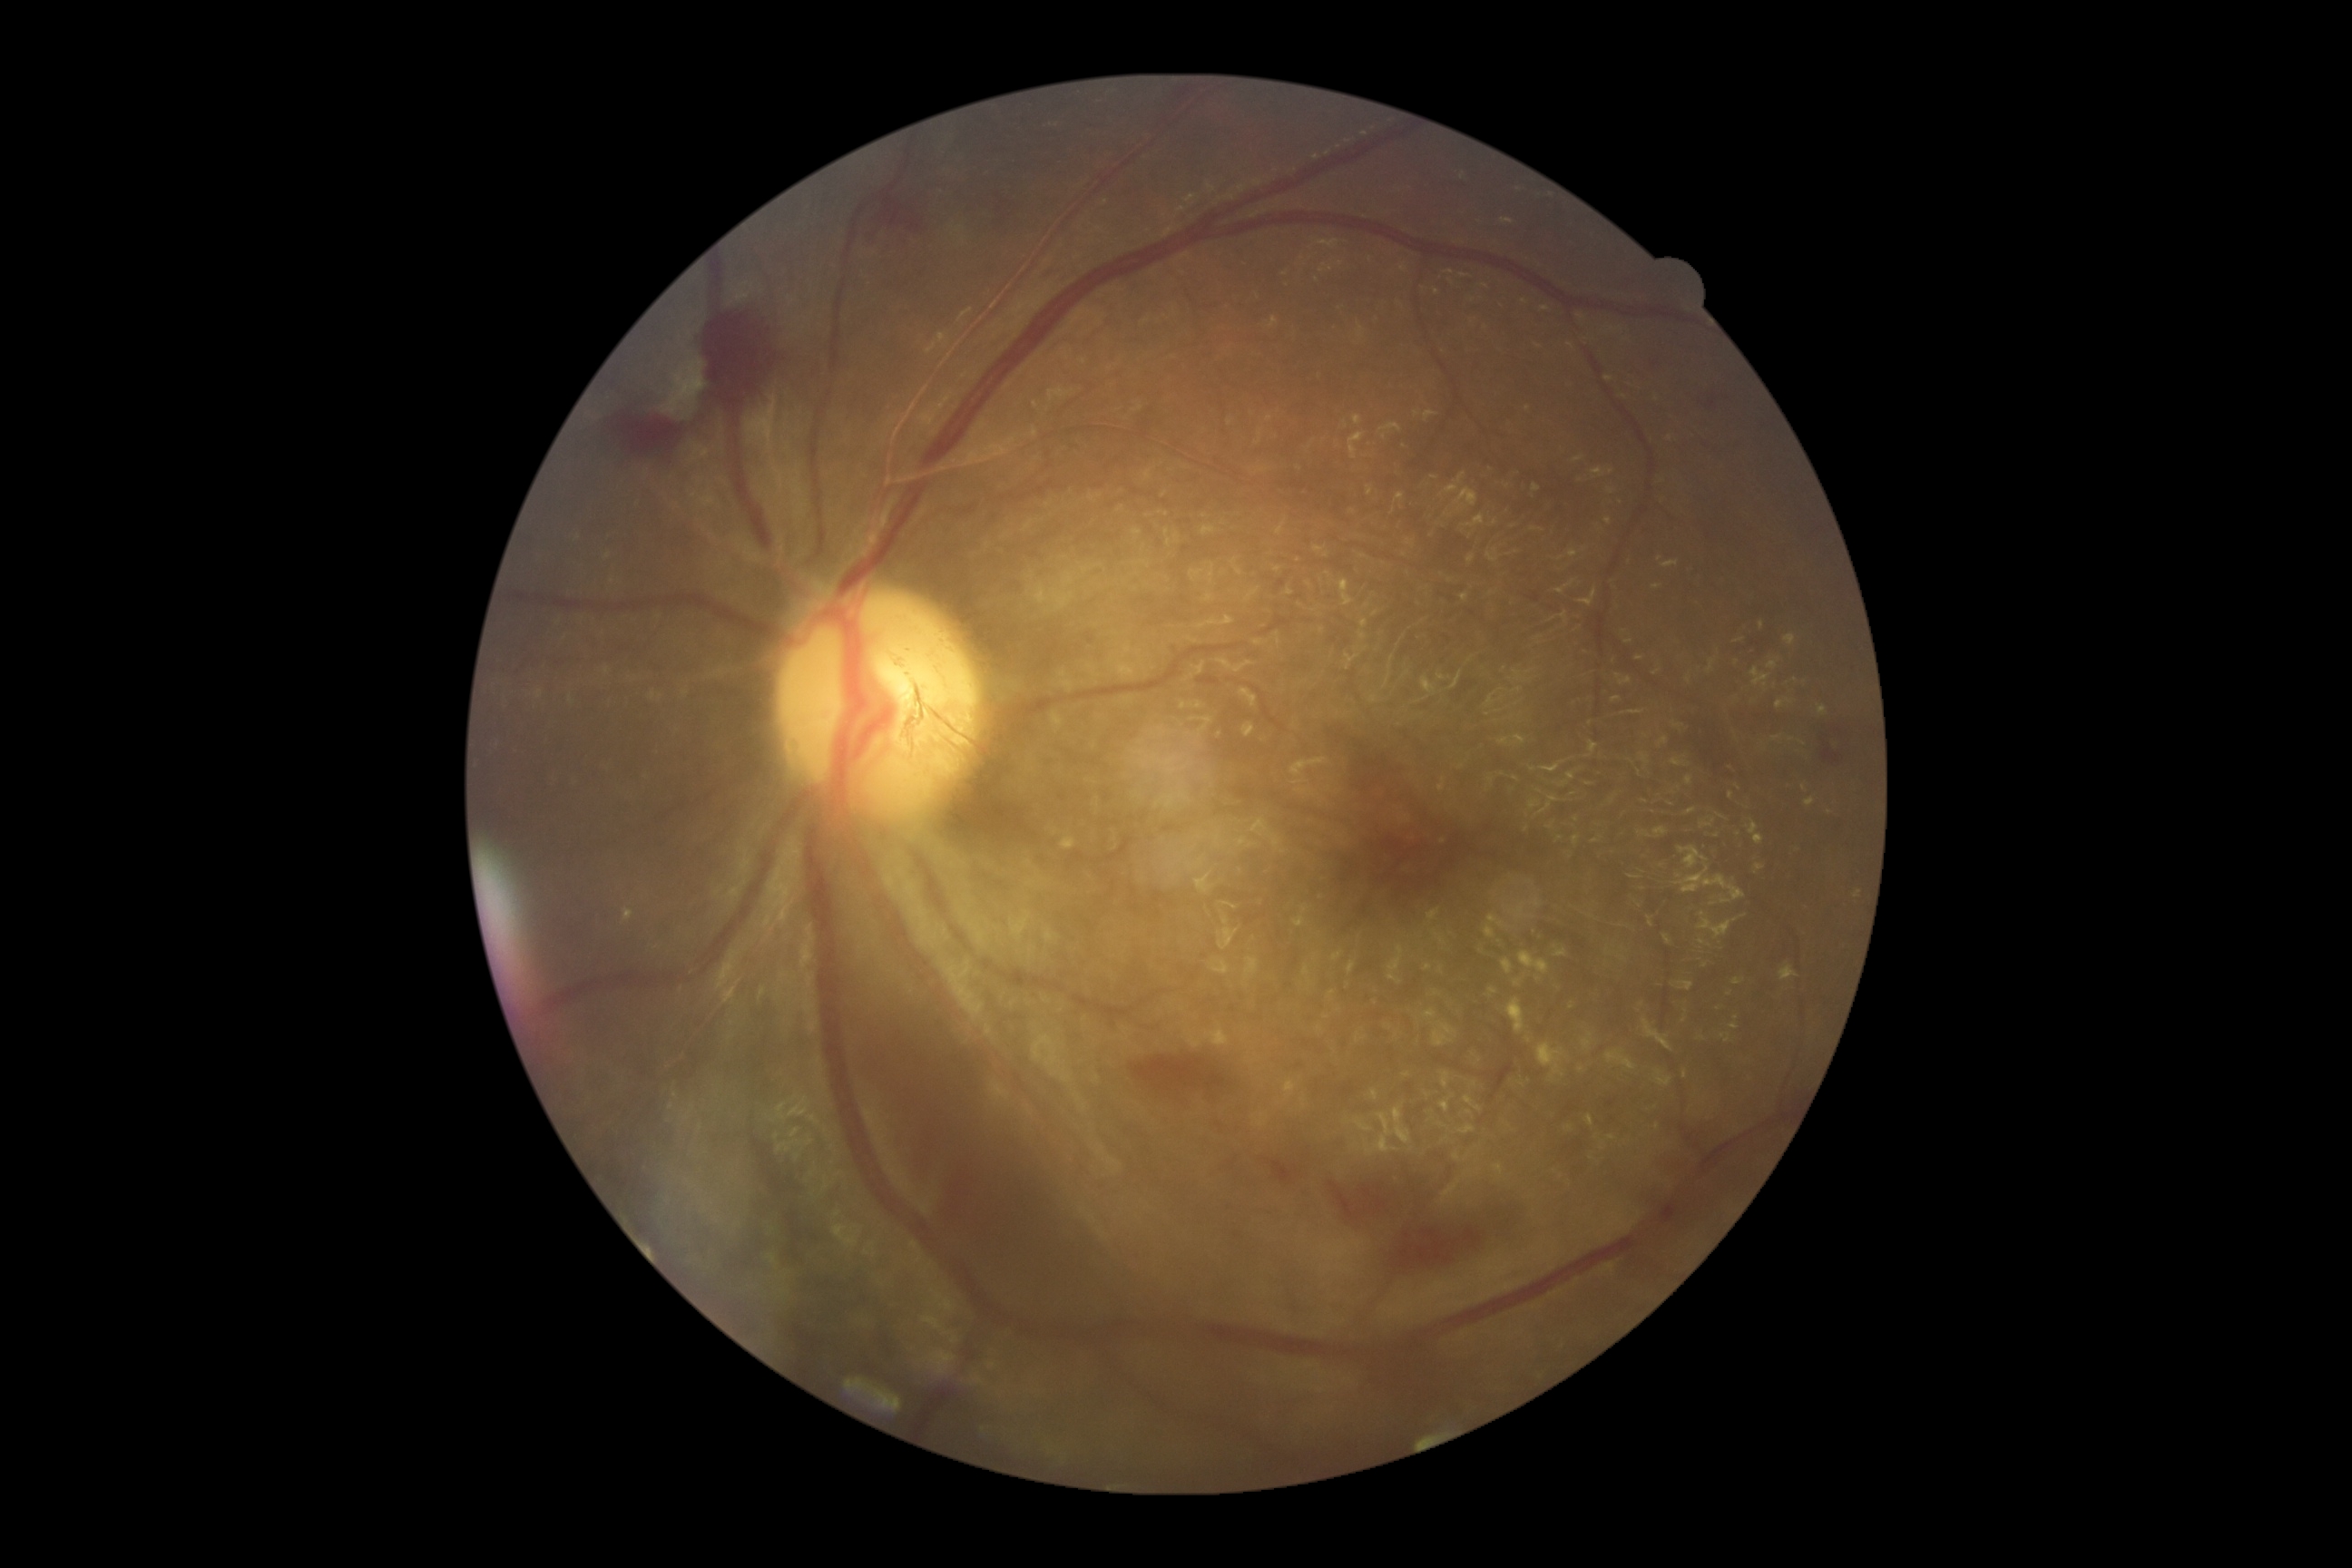

DR stage: grade 4 (PDR).